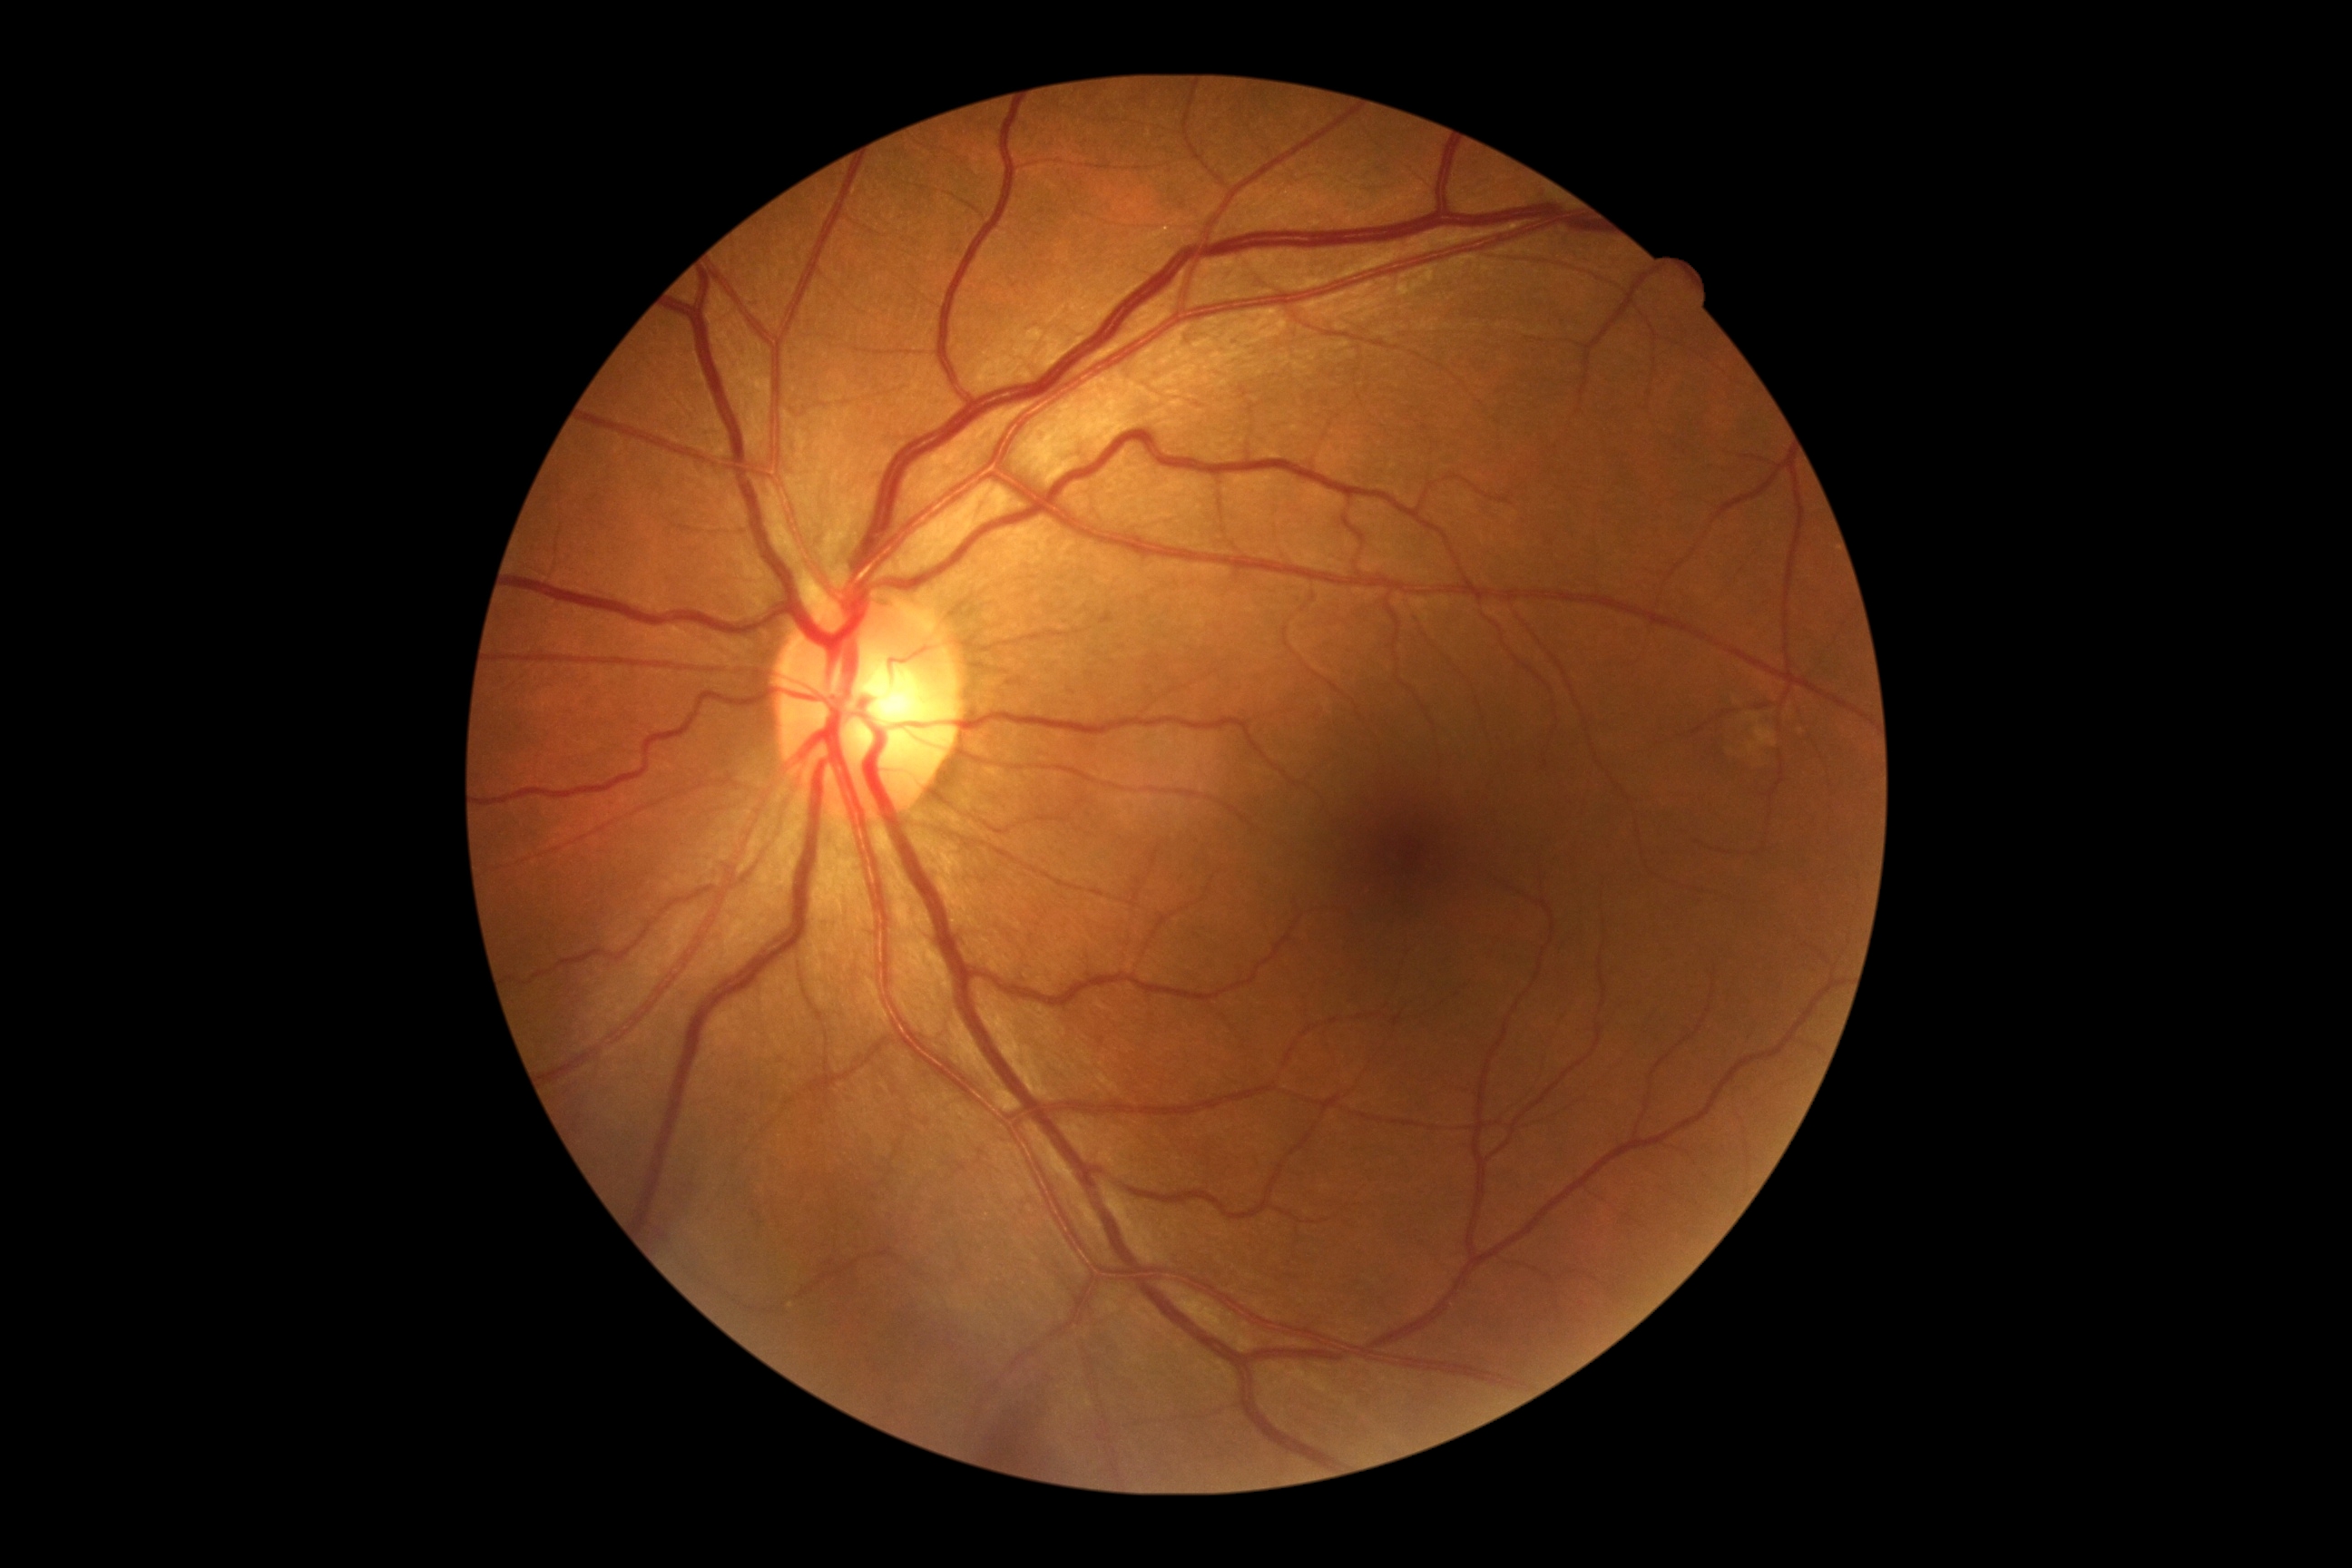 Diabetic retinopathy (DR): grade 0.